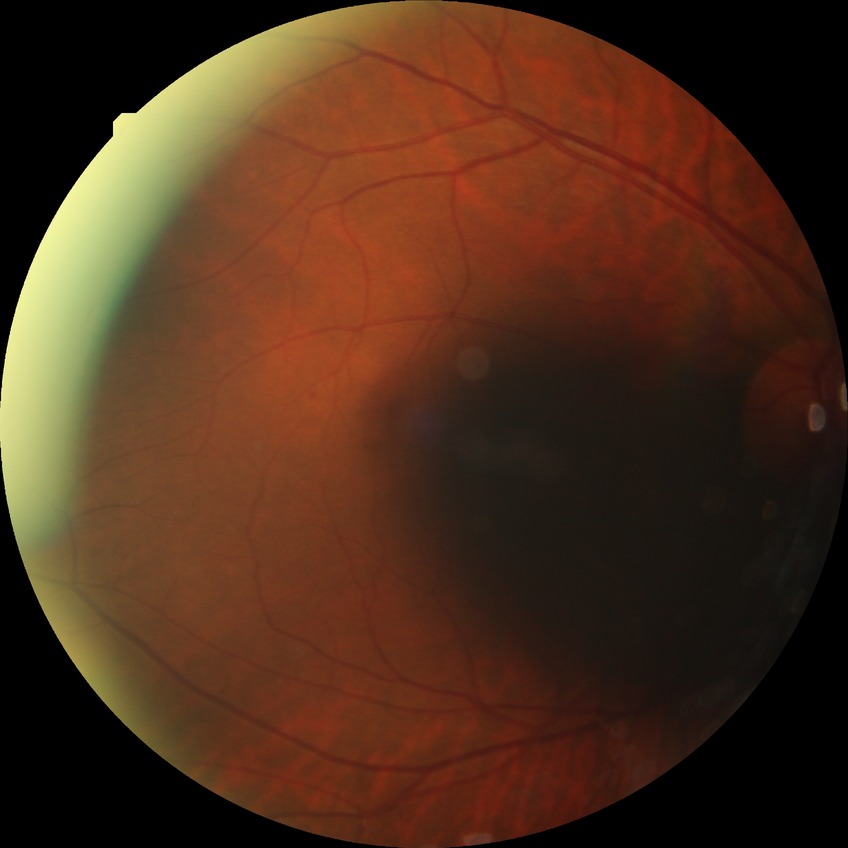 * Davis grading: simple diabetic retinopathy